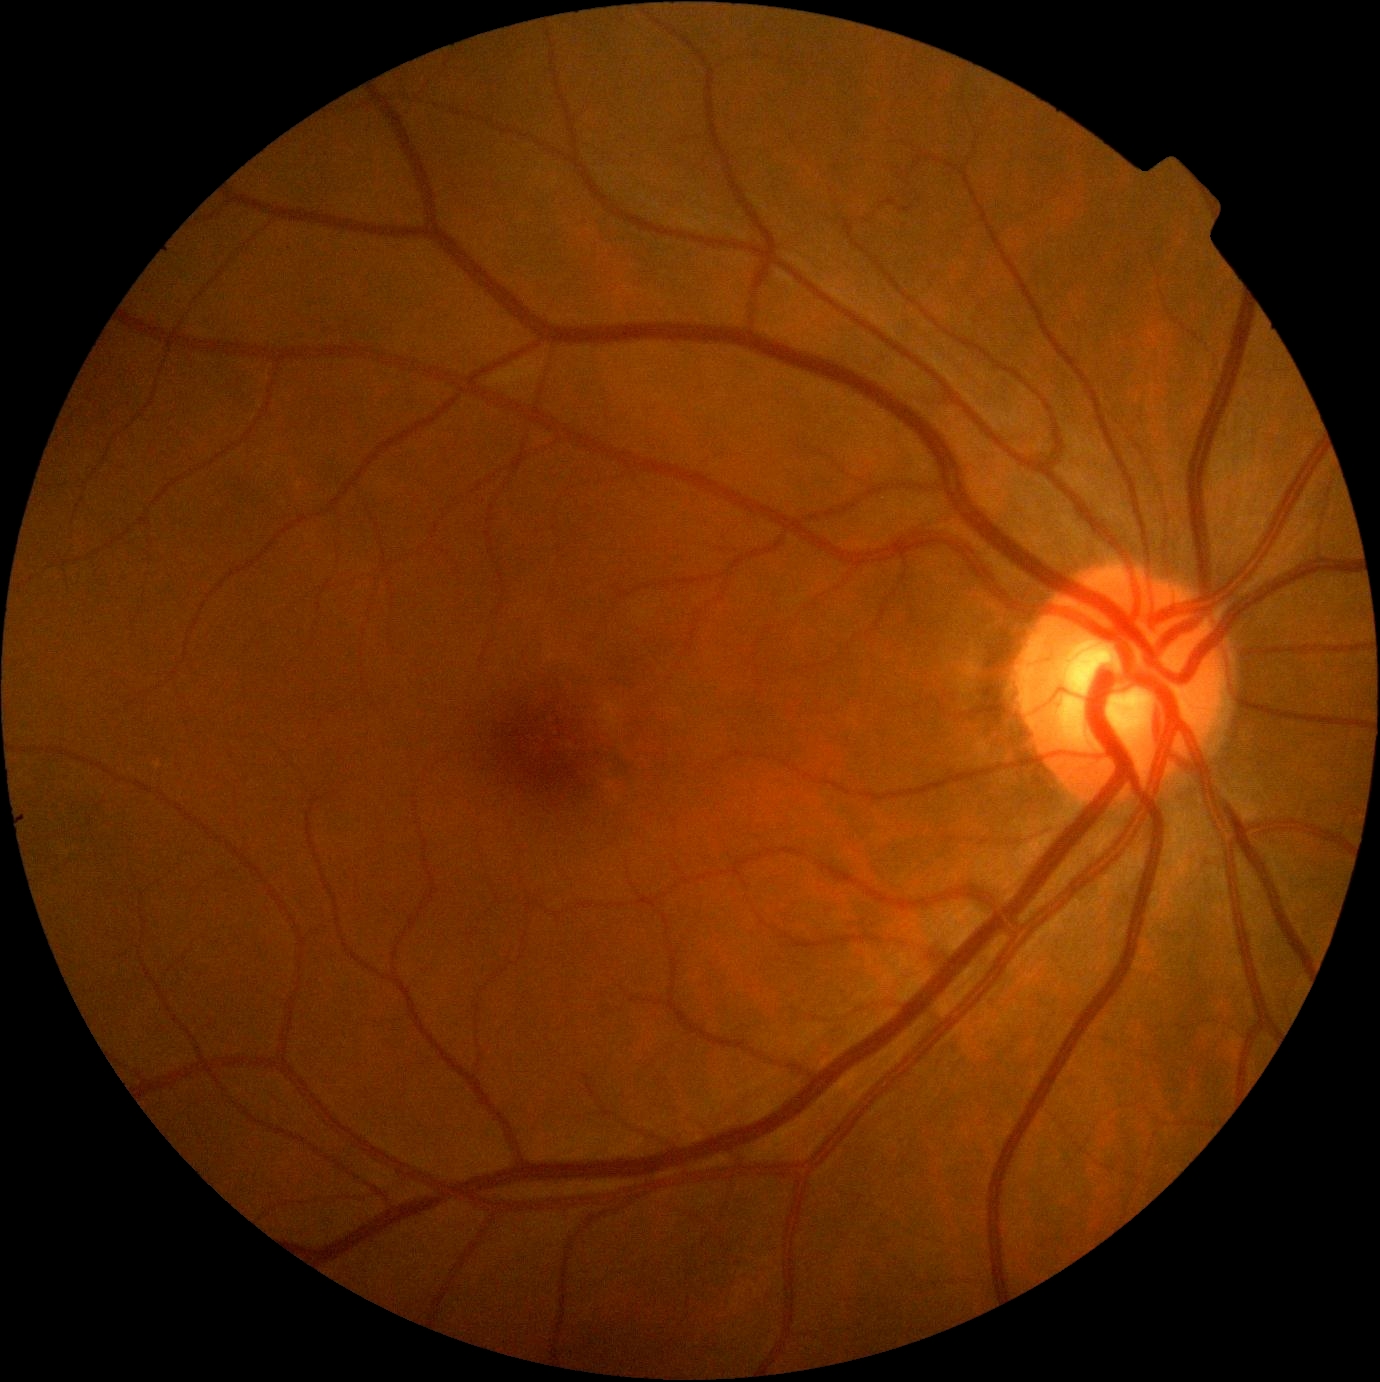
No diabetic retinal disease findings. DR stage: grade 0.